Color fundus image.
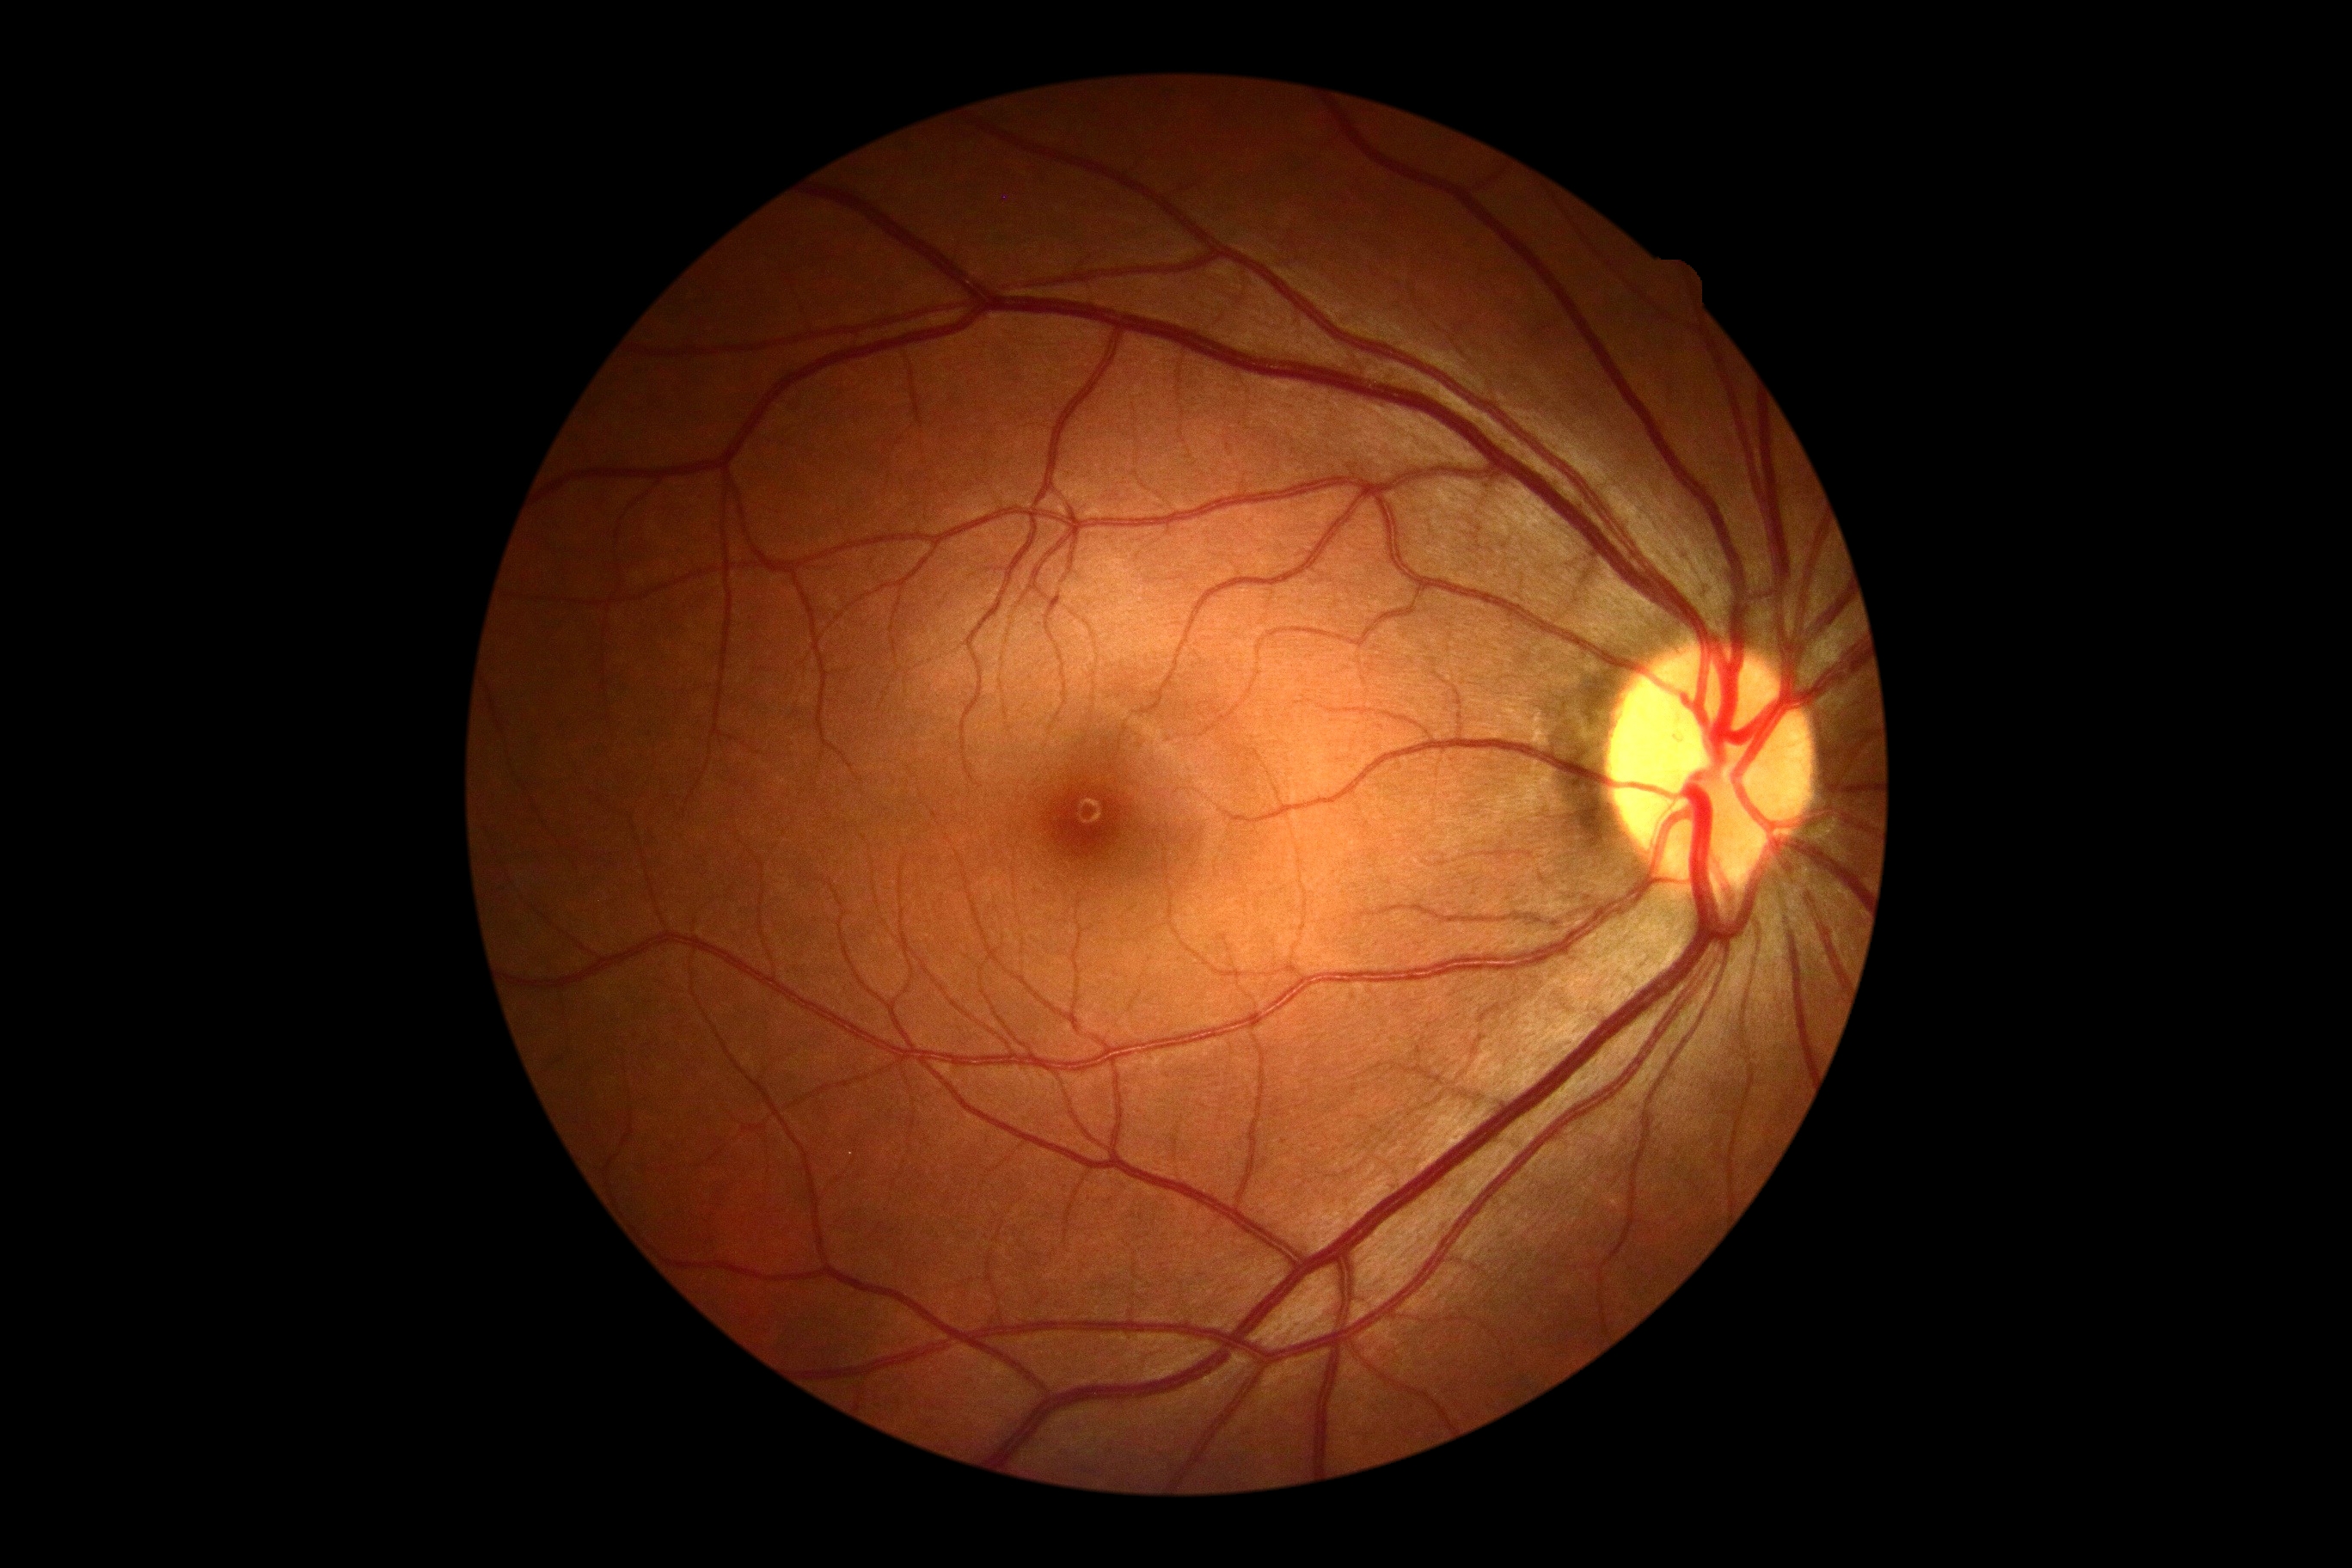 - diabetic retinopathy (DR): grade 0